Retinal fundus photograph. 2184x1690px — 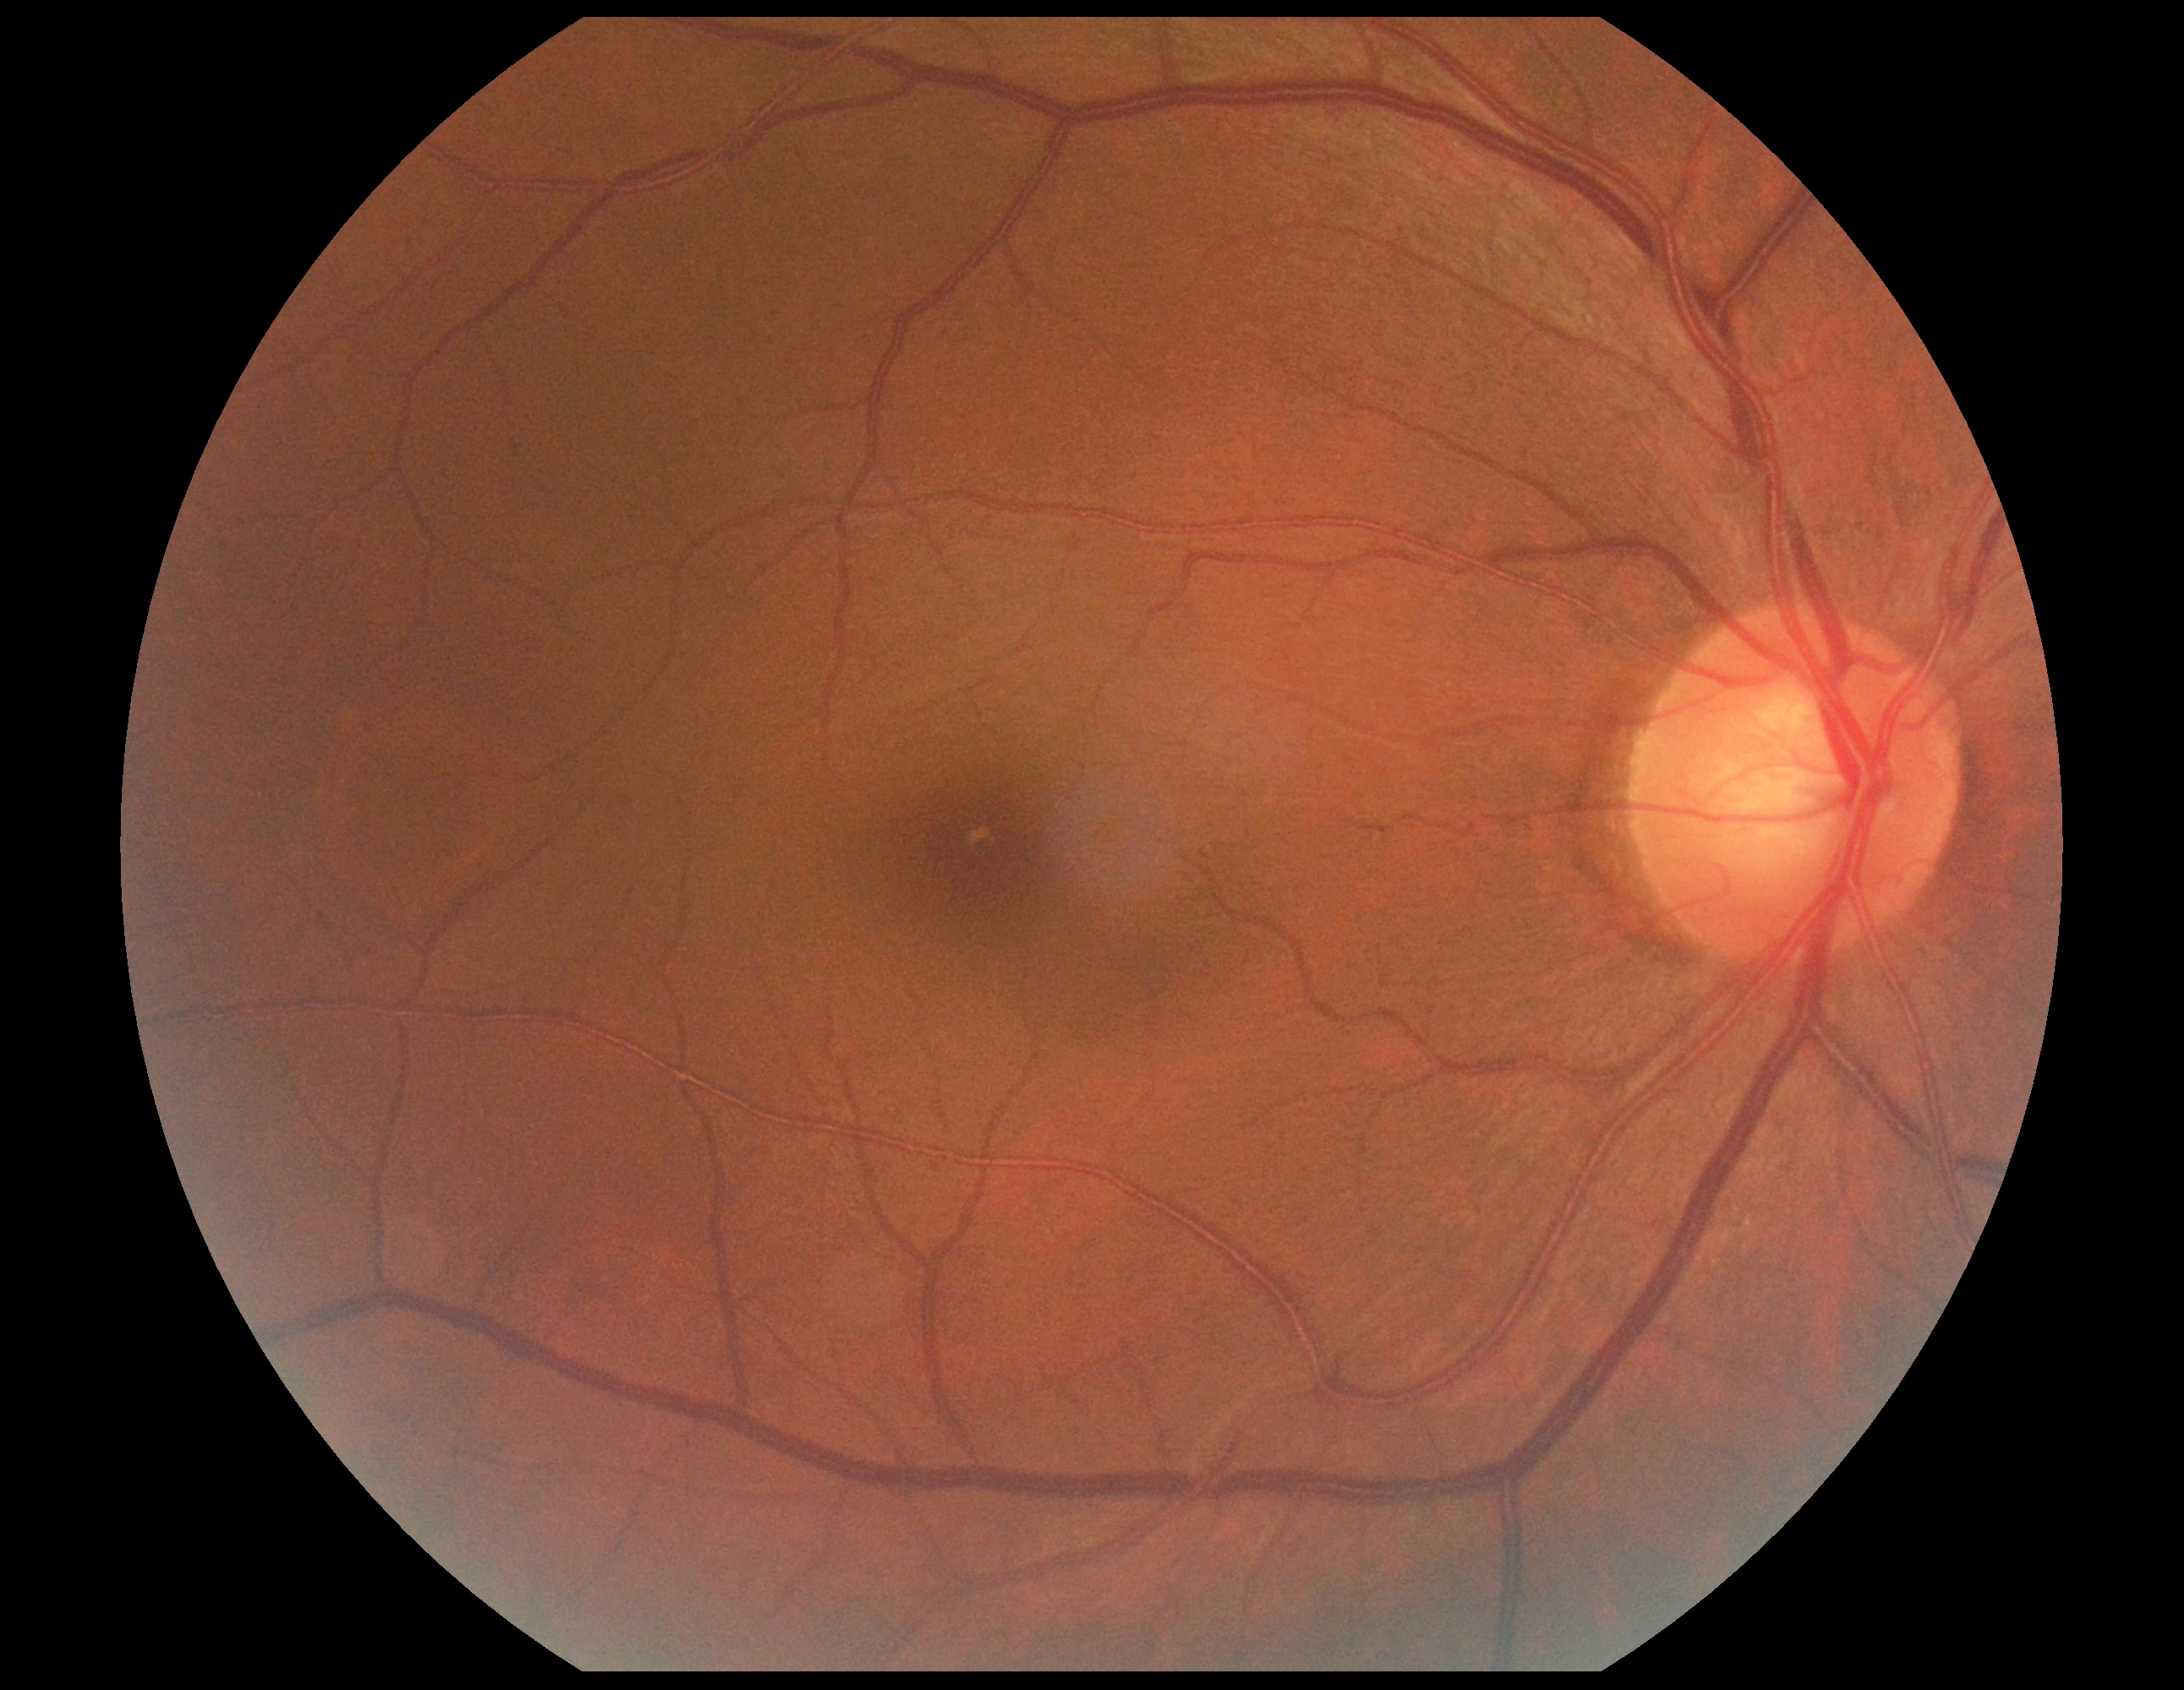
Diabetic retinopathy (DR) is grade 0 (no apparent retinopathy).